Color fundus photograph:
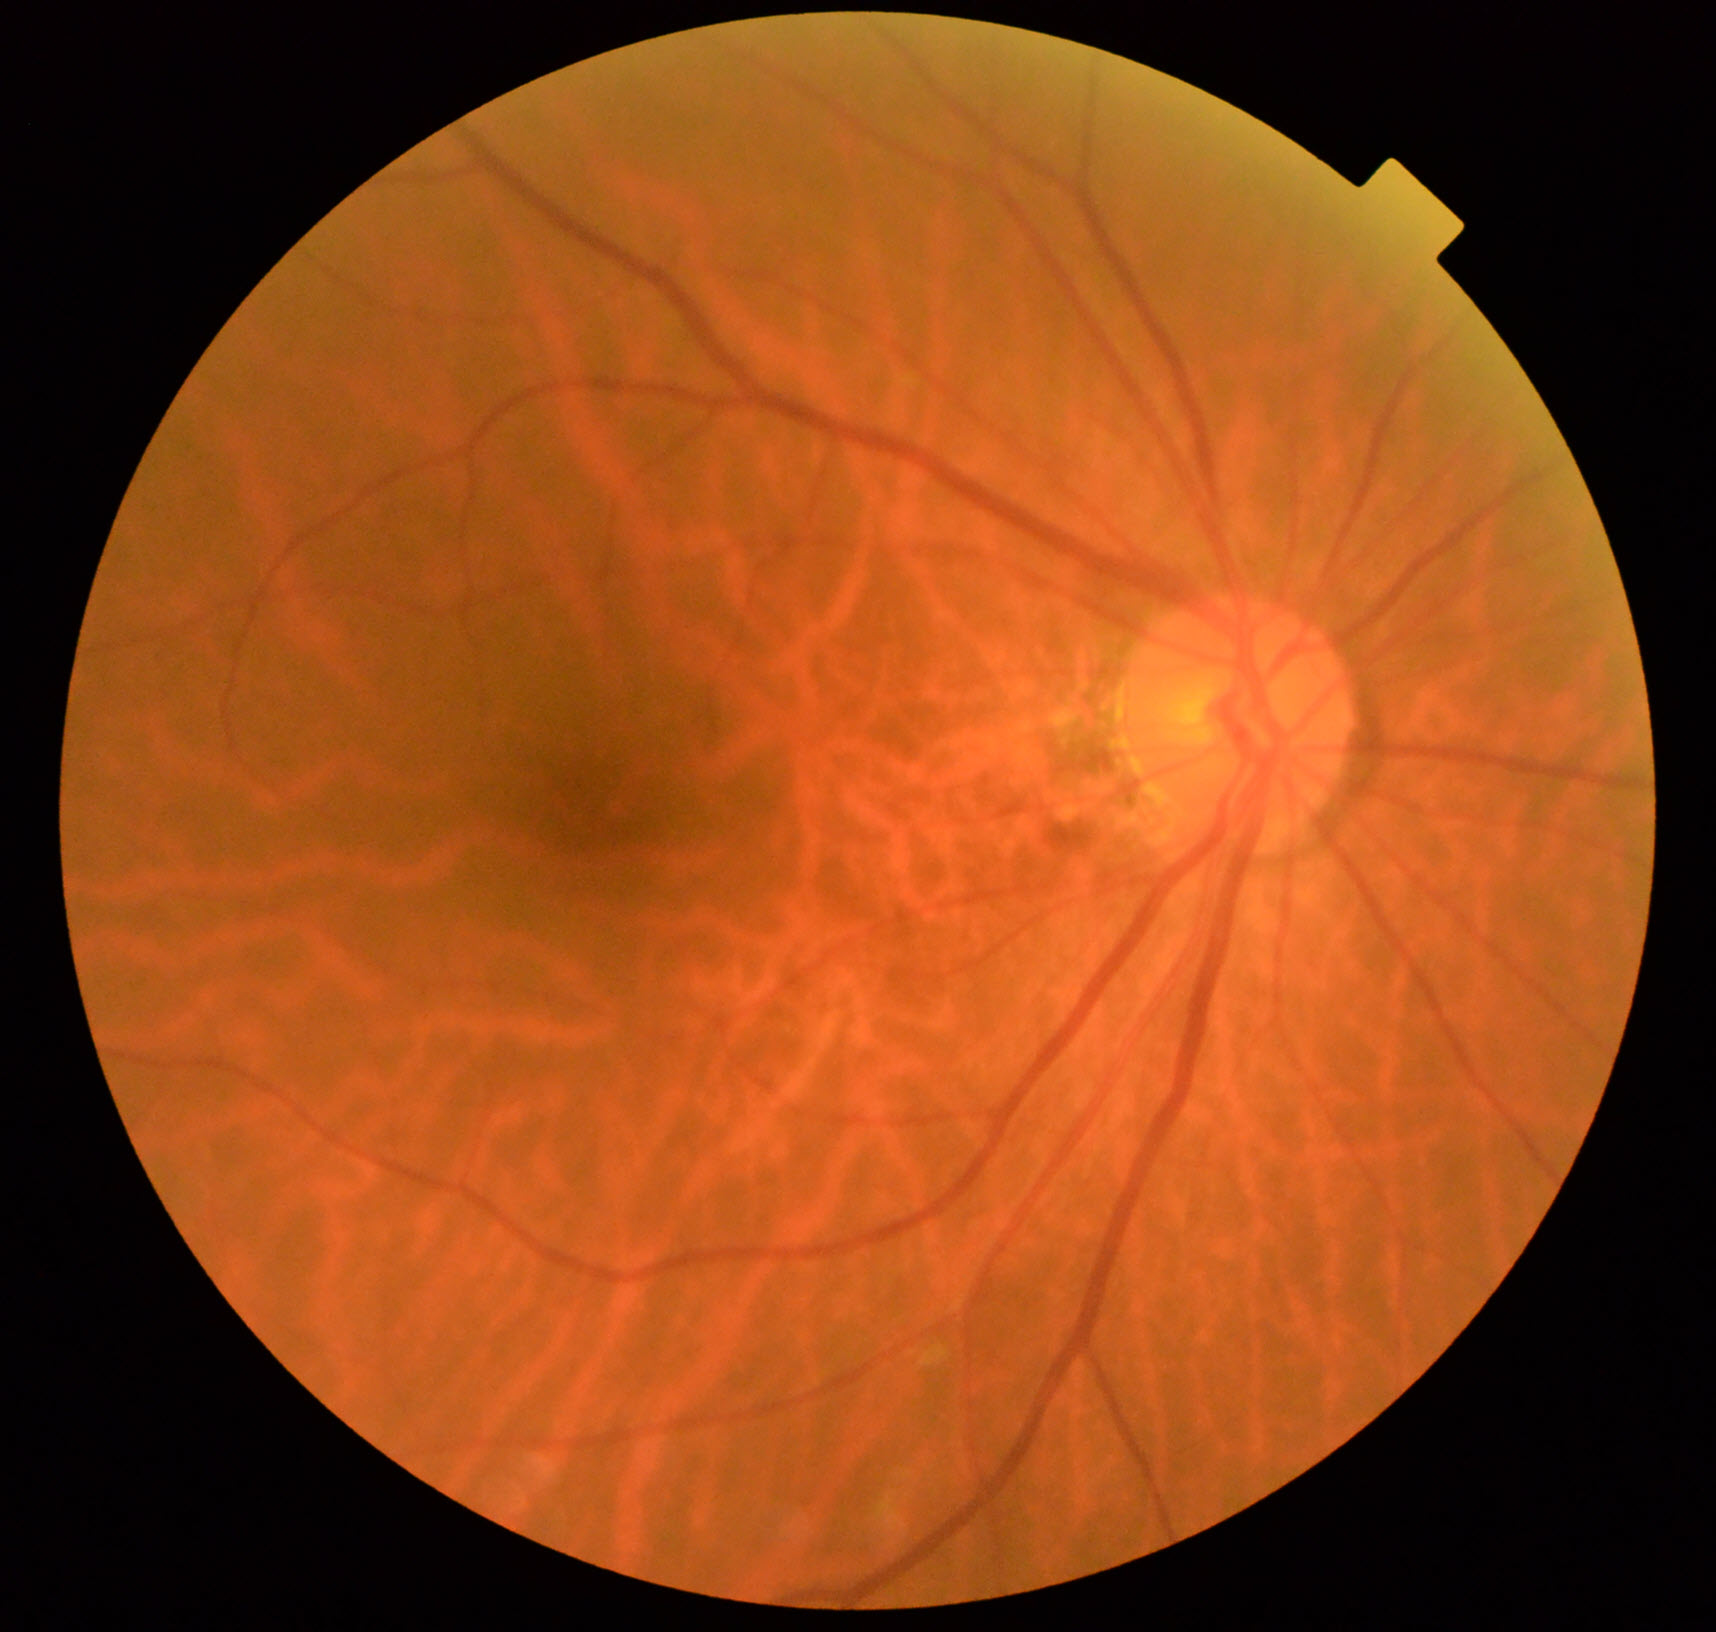

Findings: tessellated fundus.